Cropped to the optic nerve head:
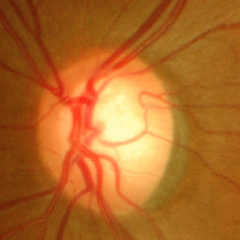 Optic disc appearance consistent with no signs of glaucoma.